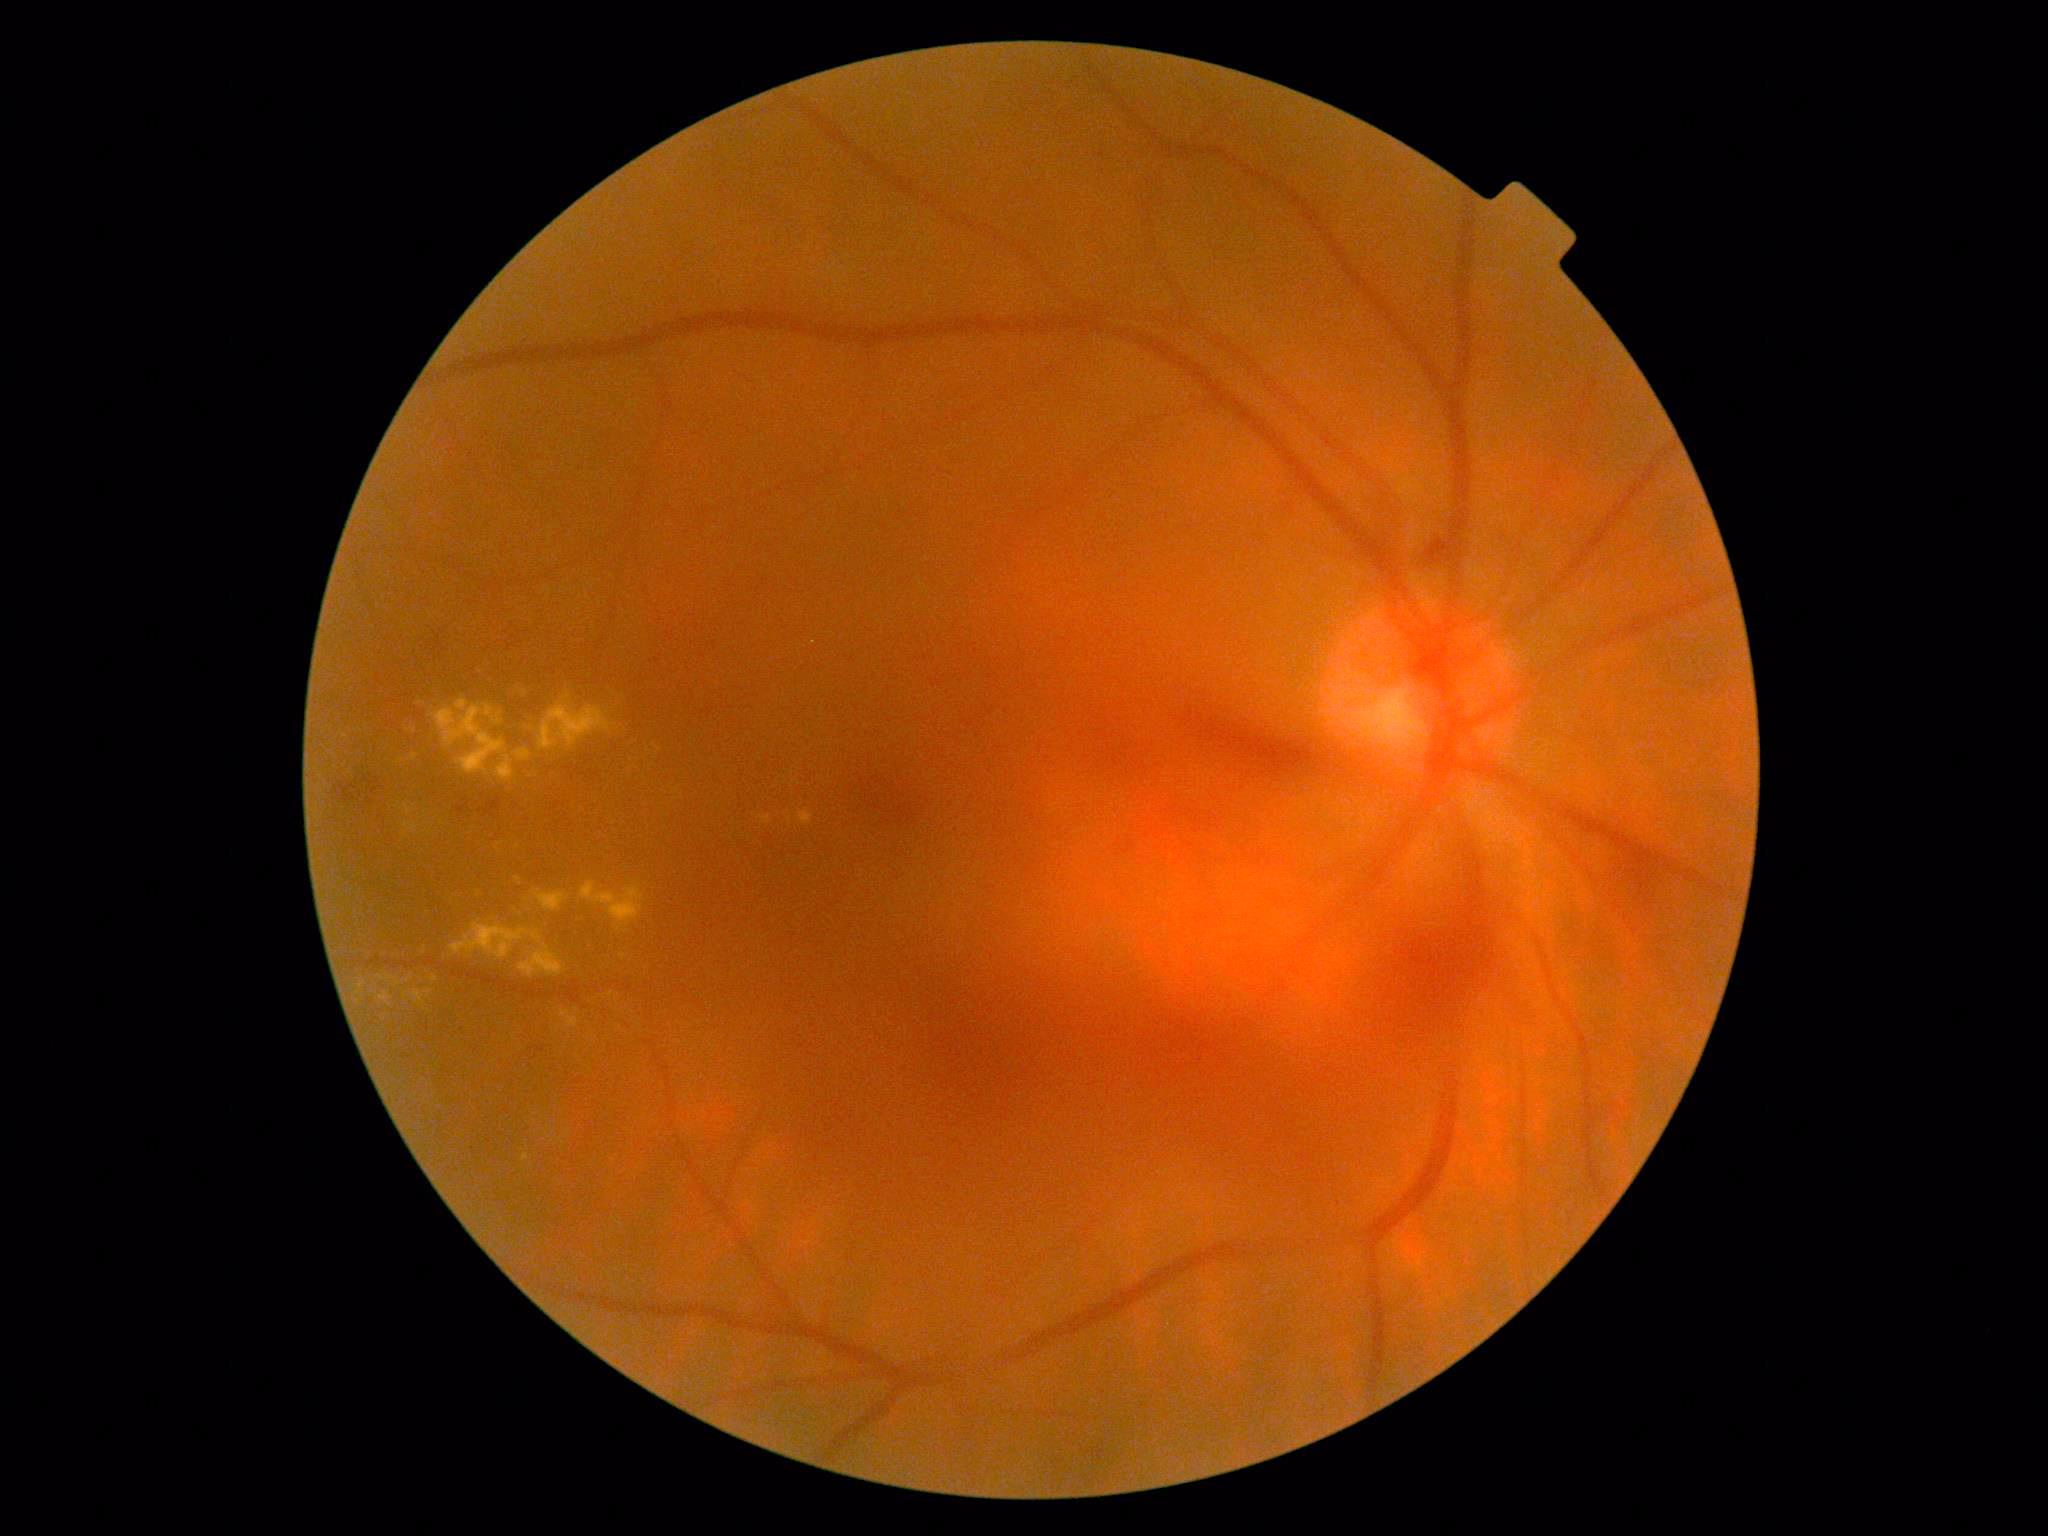
Diabetic retinopathy is 4/4
Selected lesions:
hard exudates (partial): 379,975,393,981; 522,1153,530,1162; 532,890,568,911; 404,823,417,833; 799,810,815,826; 581,883,645,930; 538,703,612,750; 380,991,391,1006; 493,712,502,725
Additional small hard exudates near pt(425, 951); pt(434, 979); pt(414, 757); pt(526, 692); pt(402, 761); pt(429, 834); pt(407, 981); pt(500, 844)